45° FOV · color fundus photograph · 2352 x 1568 pixels — 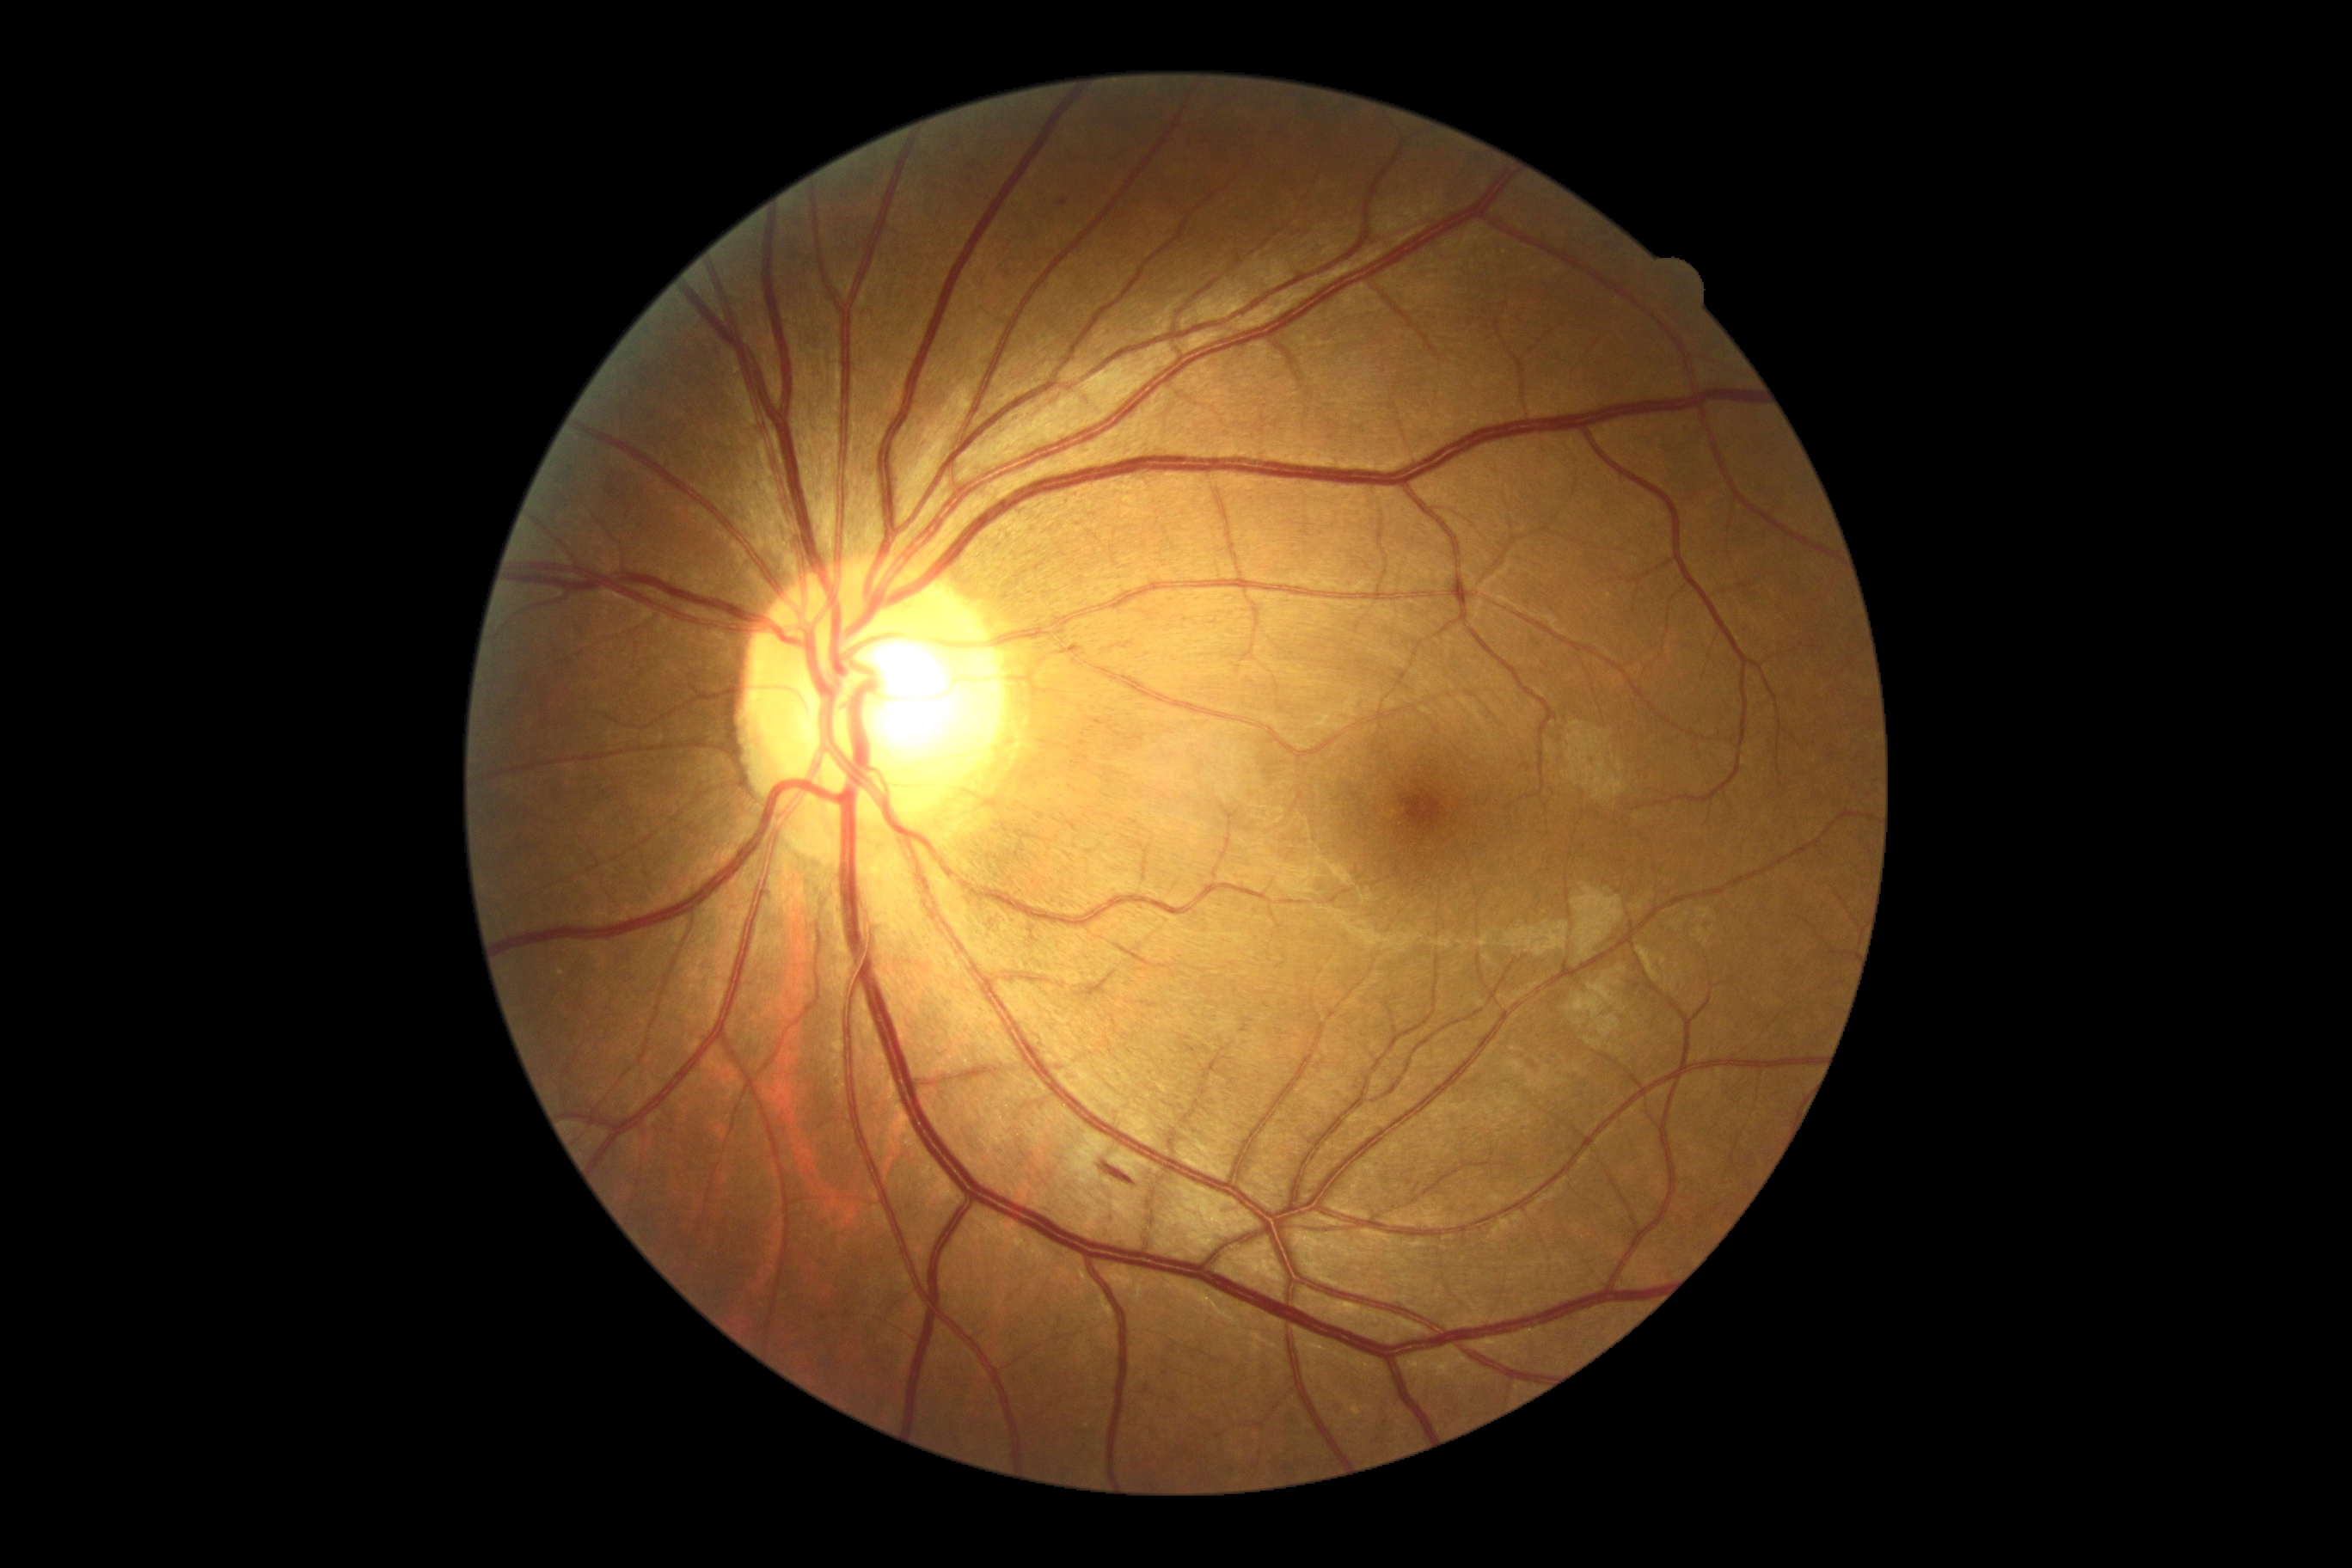 Diabetic retinopathy (DR): grade 2.